Wide-field contact fundus photograph of an infant · 640 x 480 pixels:
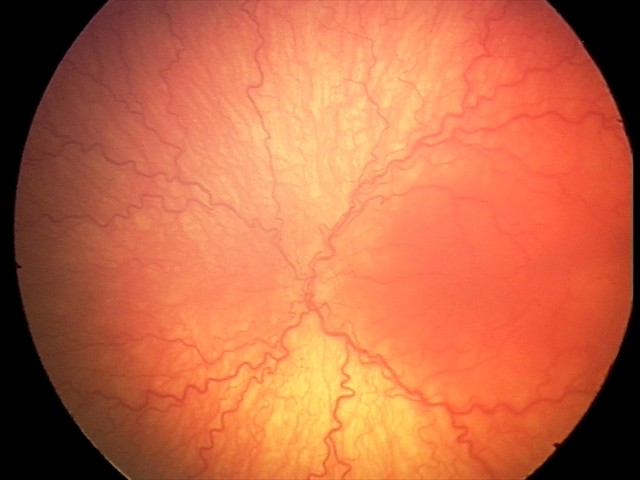 Screening examination consistent with aggressive retinopathy of prematurity.